Ultra-widefield fundus photograph — 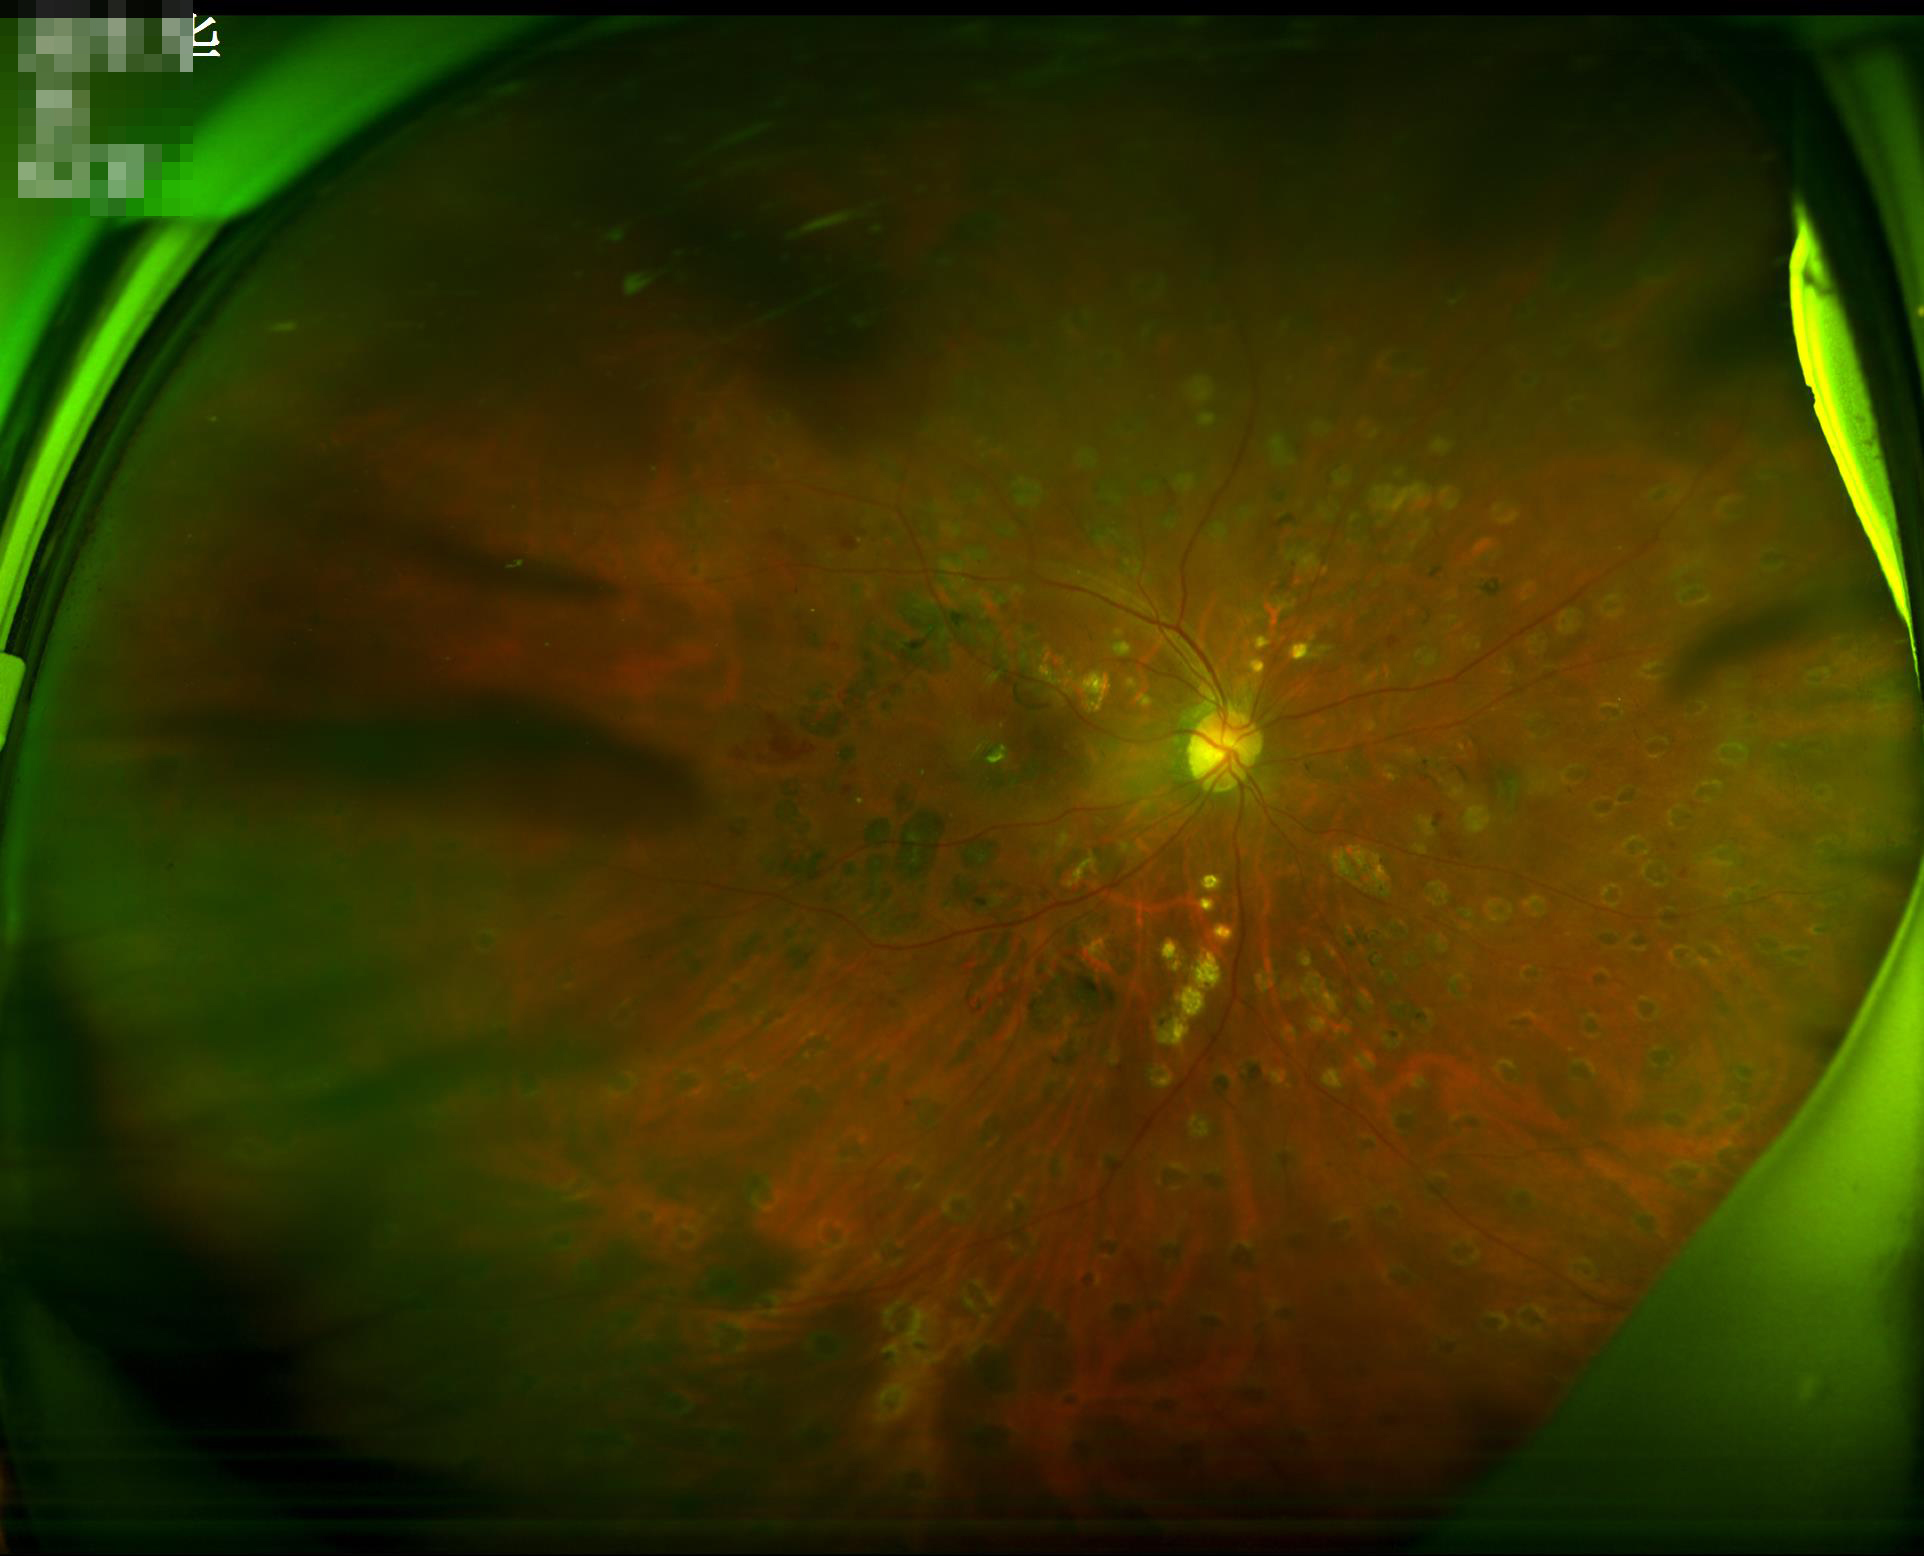 The image is blurry.
There is over- or under-exposure or a color cast.
Overall quality is poor; the image is difficult to grade.